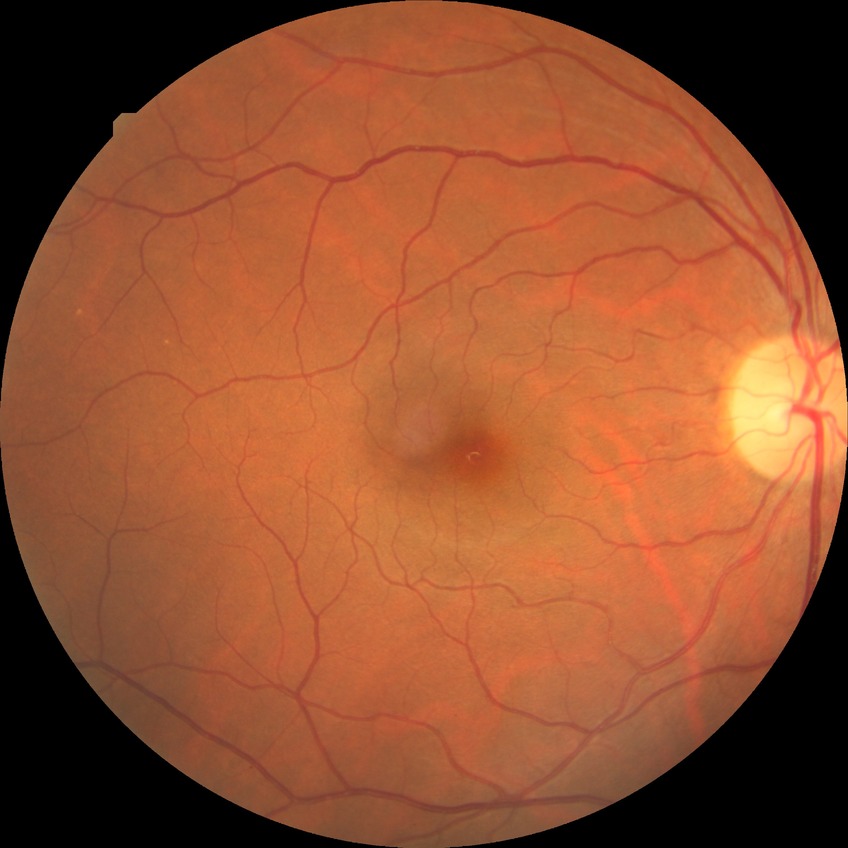
DR grade is NDR.